45-degree field of view; image size 2352x1568
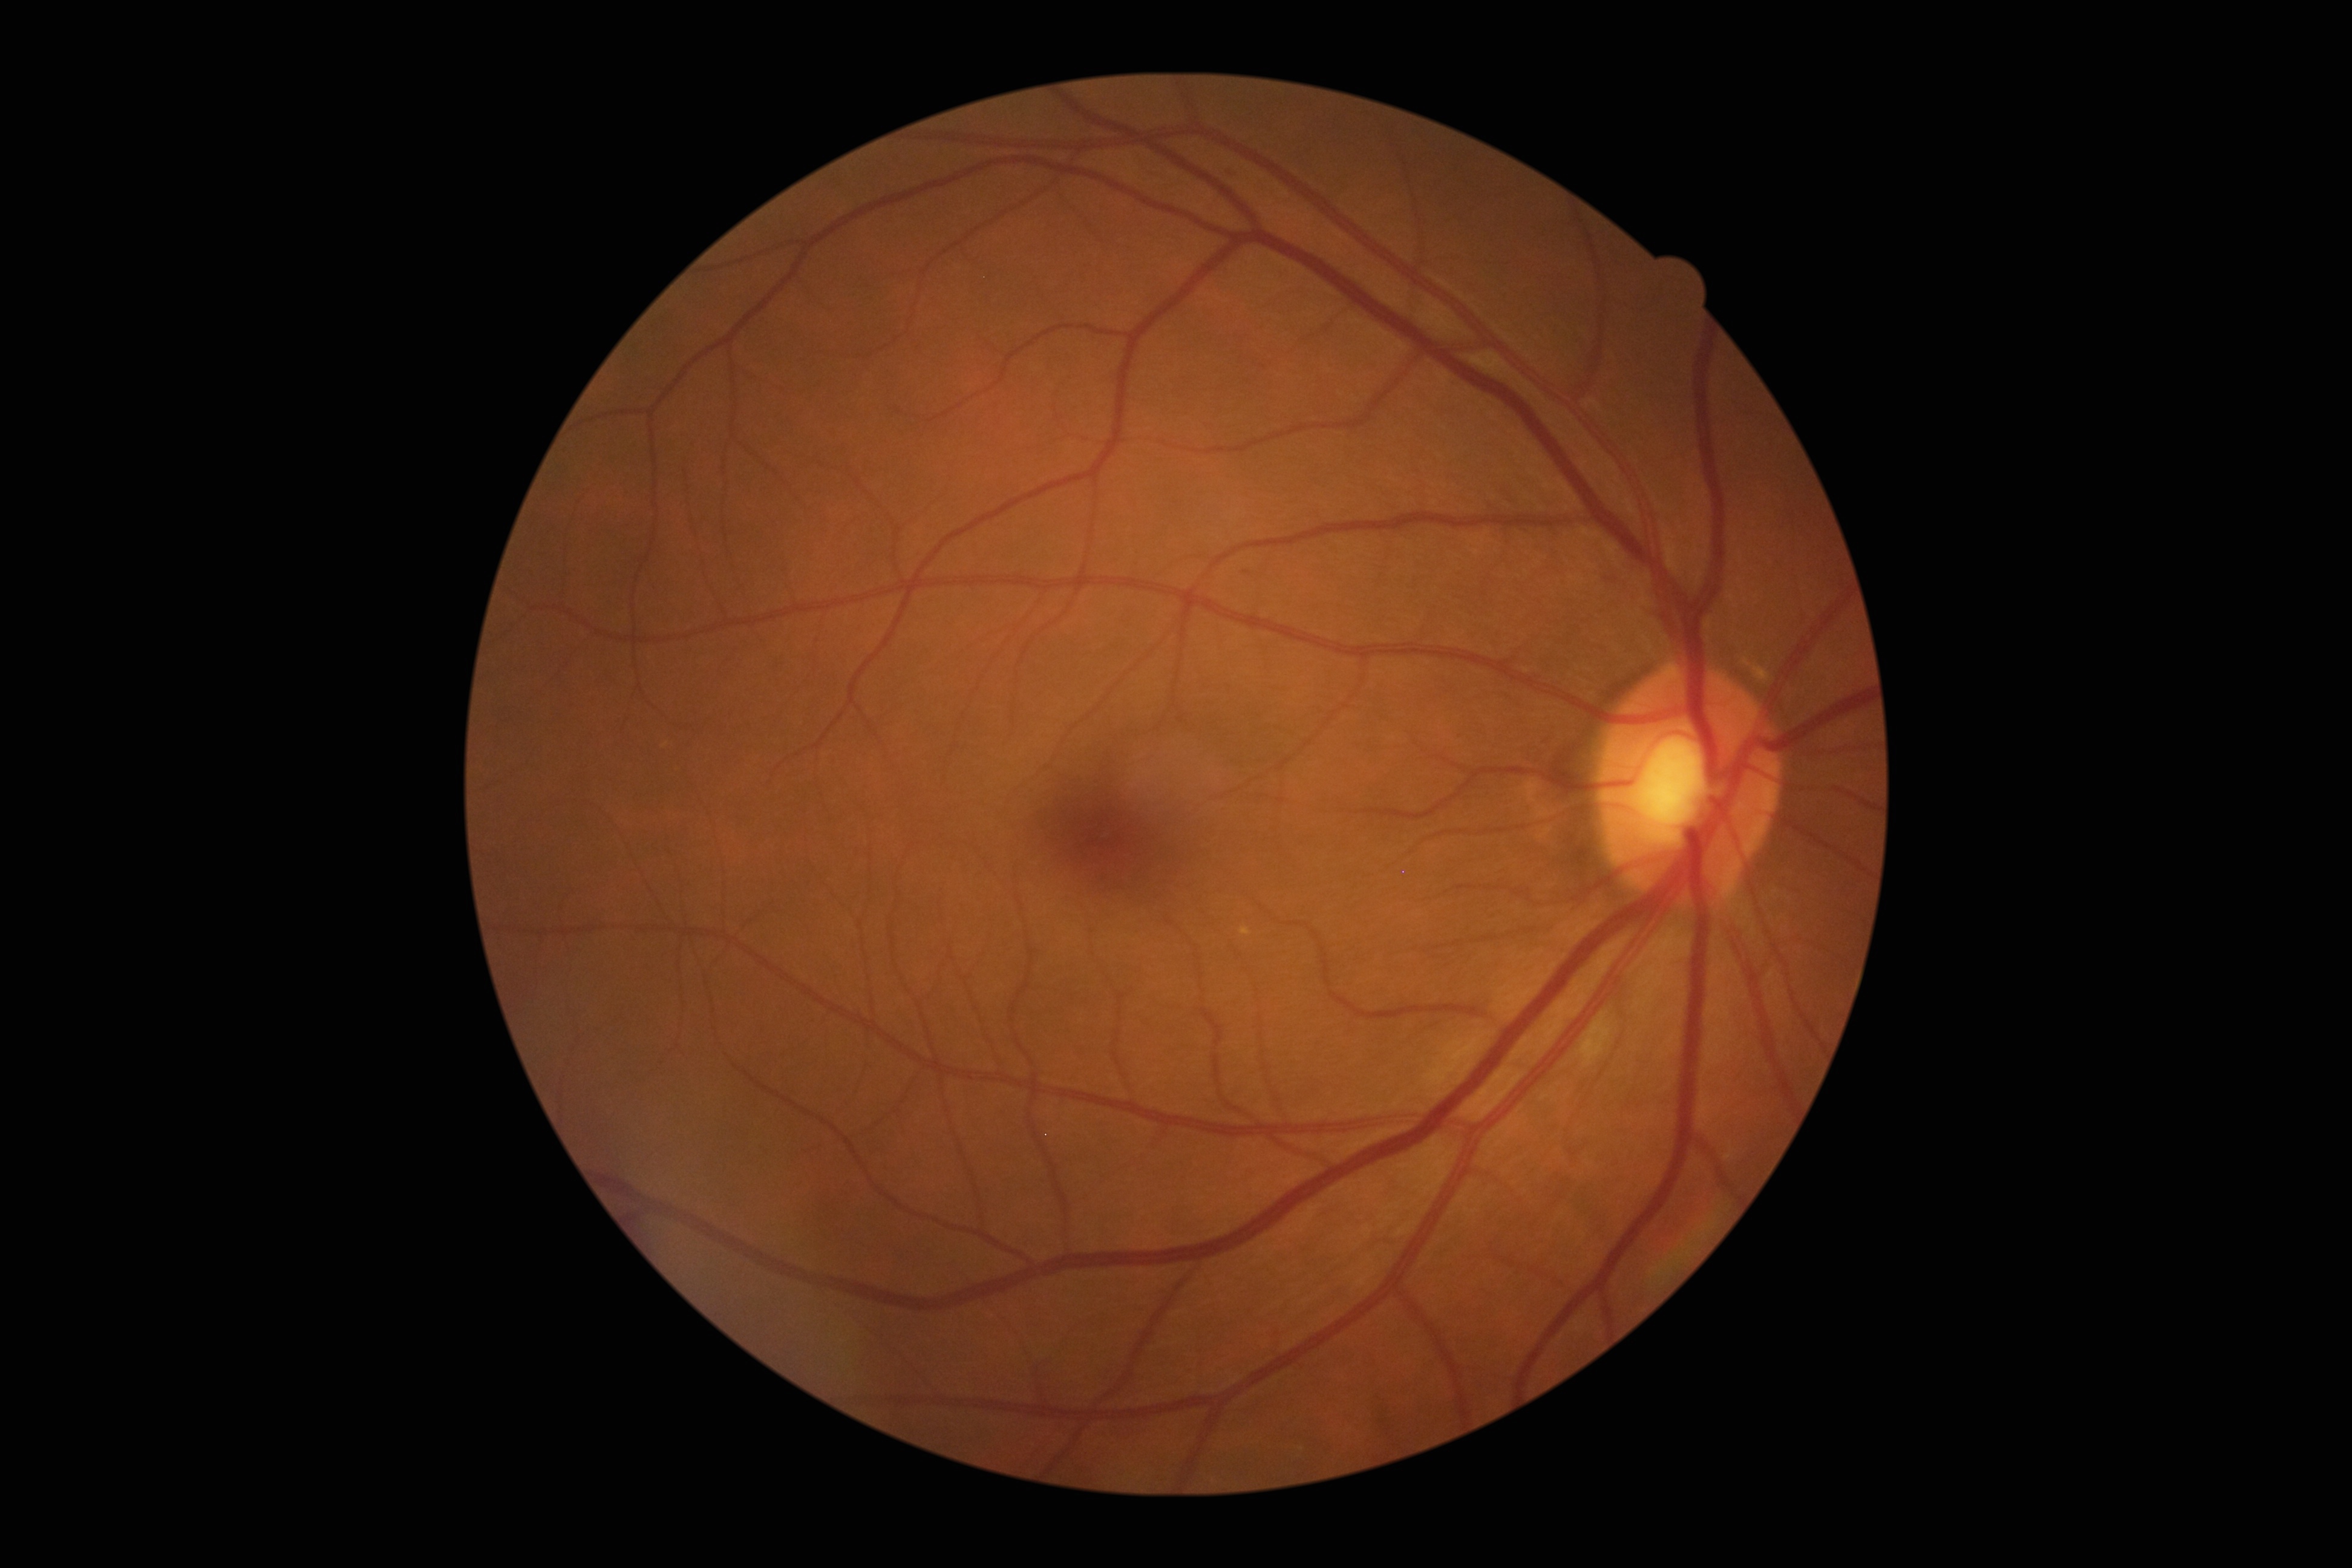

Diabetic retinopathy grade is 2 (moderate NPDR) — more than just microaneurysms but less than severe NPDR.
Disease class: non-proliferative diabetic retinopathy.